Diabetic retinopathy graded by the modified Davis classification:
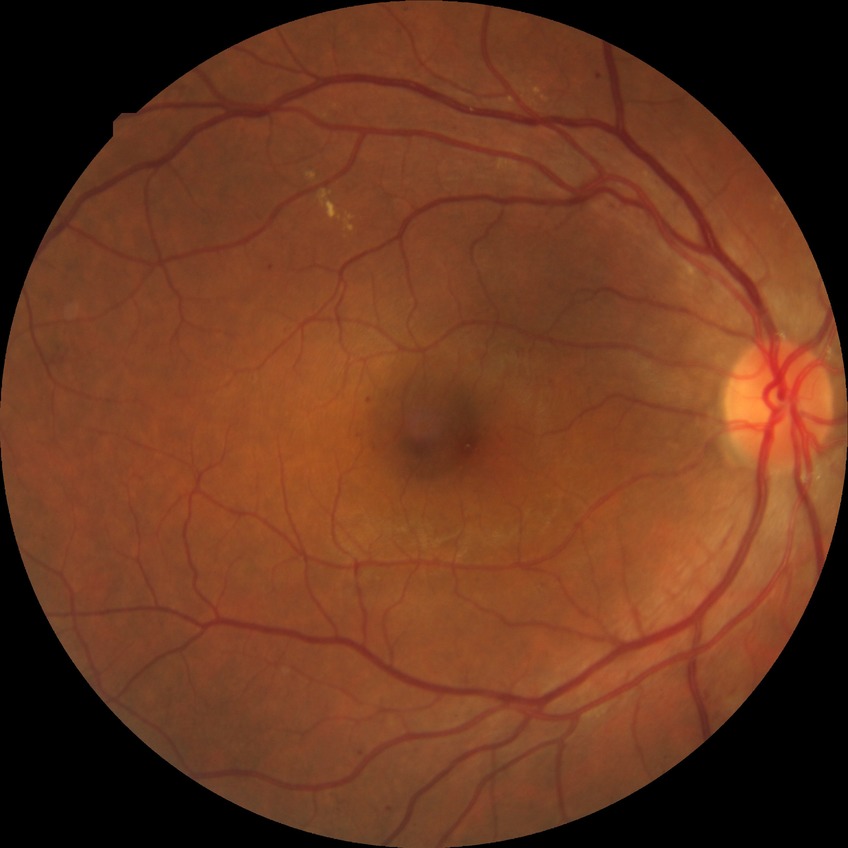 Diabetic retinopathy (DR): PPDR (pre-proliferative diabetic retinopathy).